Infant wide-field retinal image — 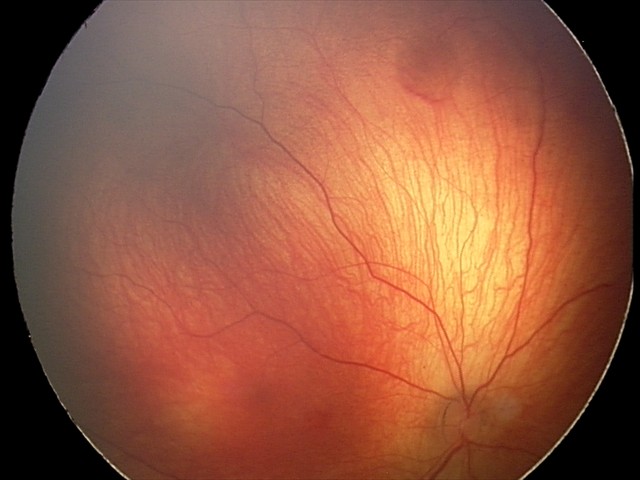

Finding: retinal hemorrhages.